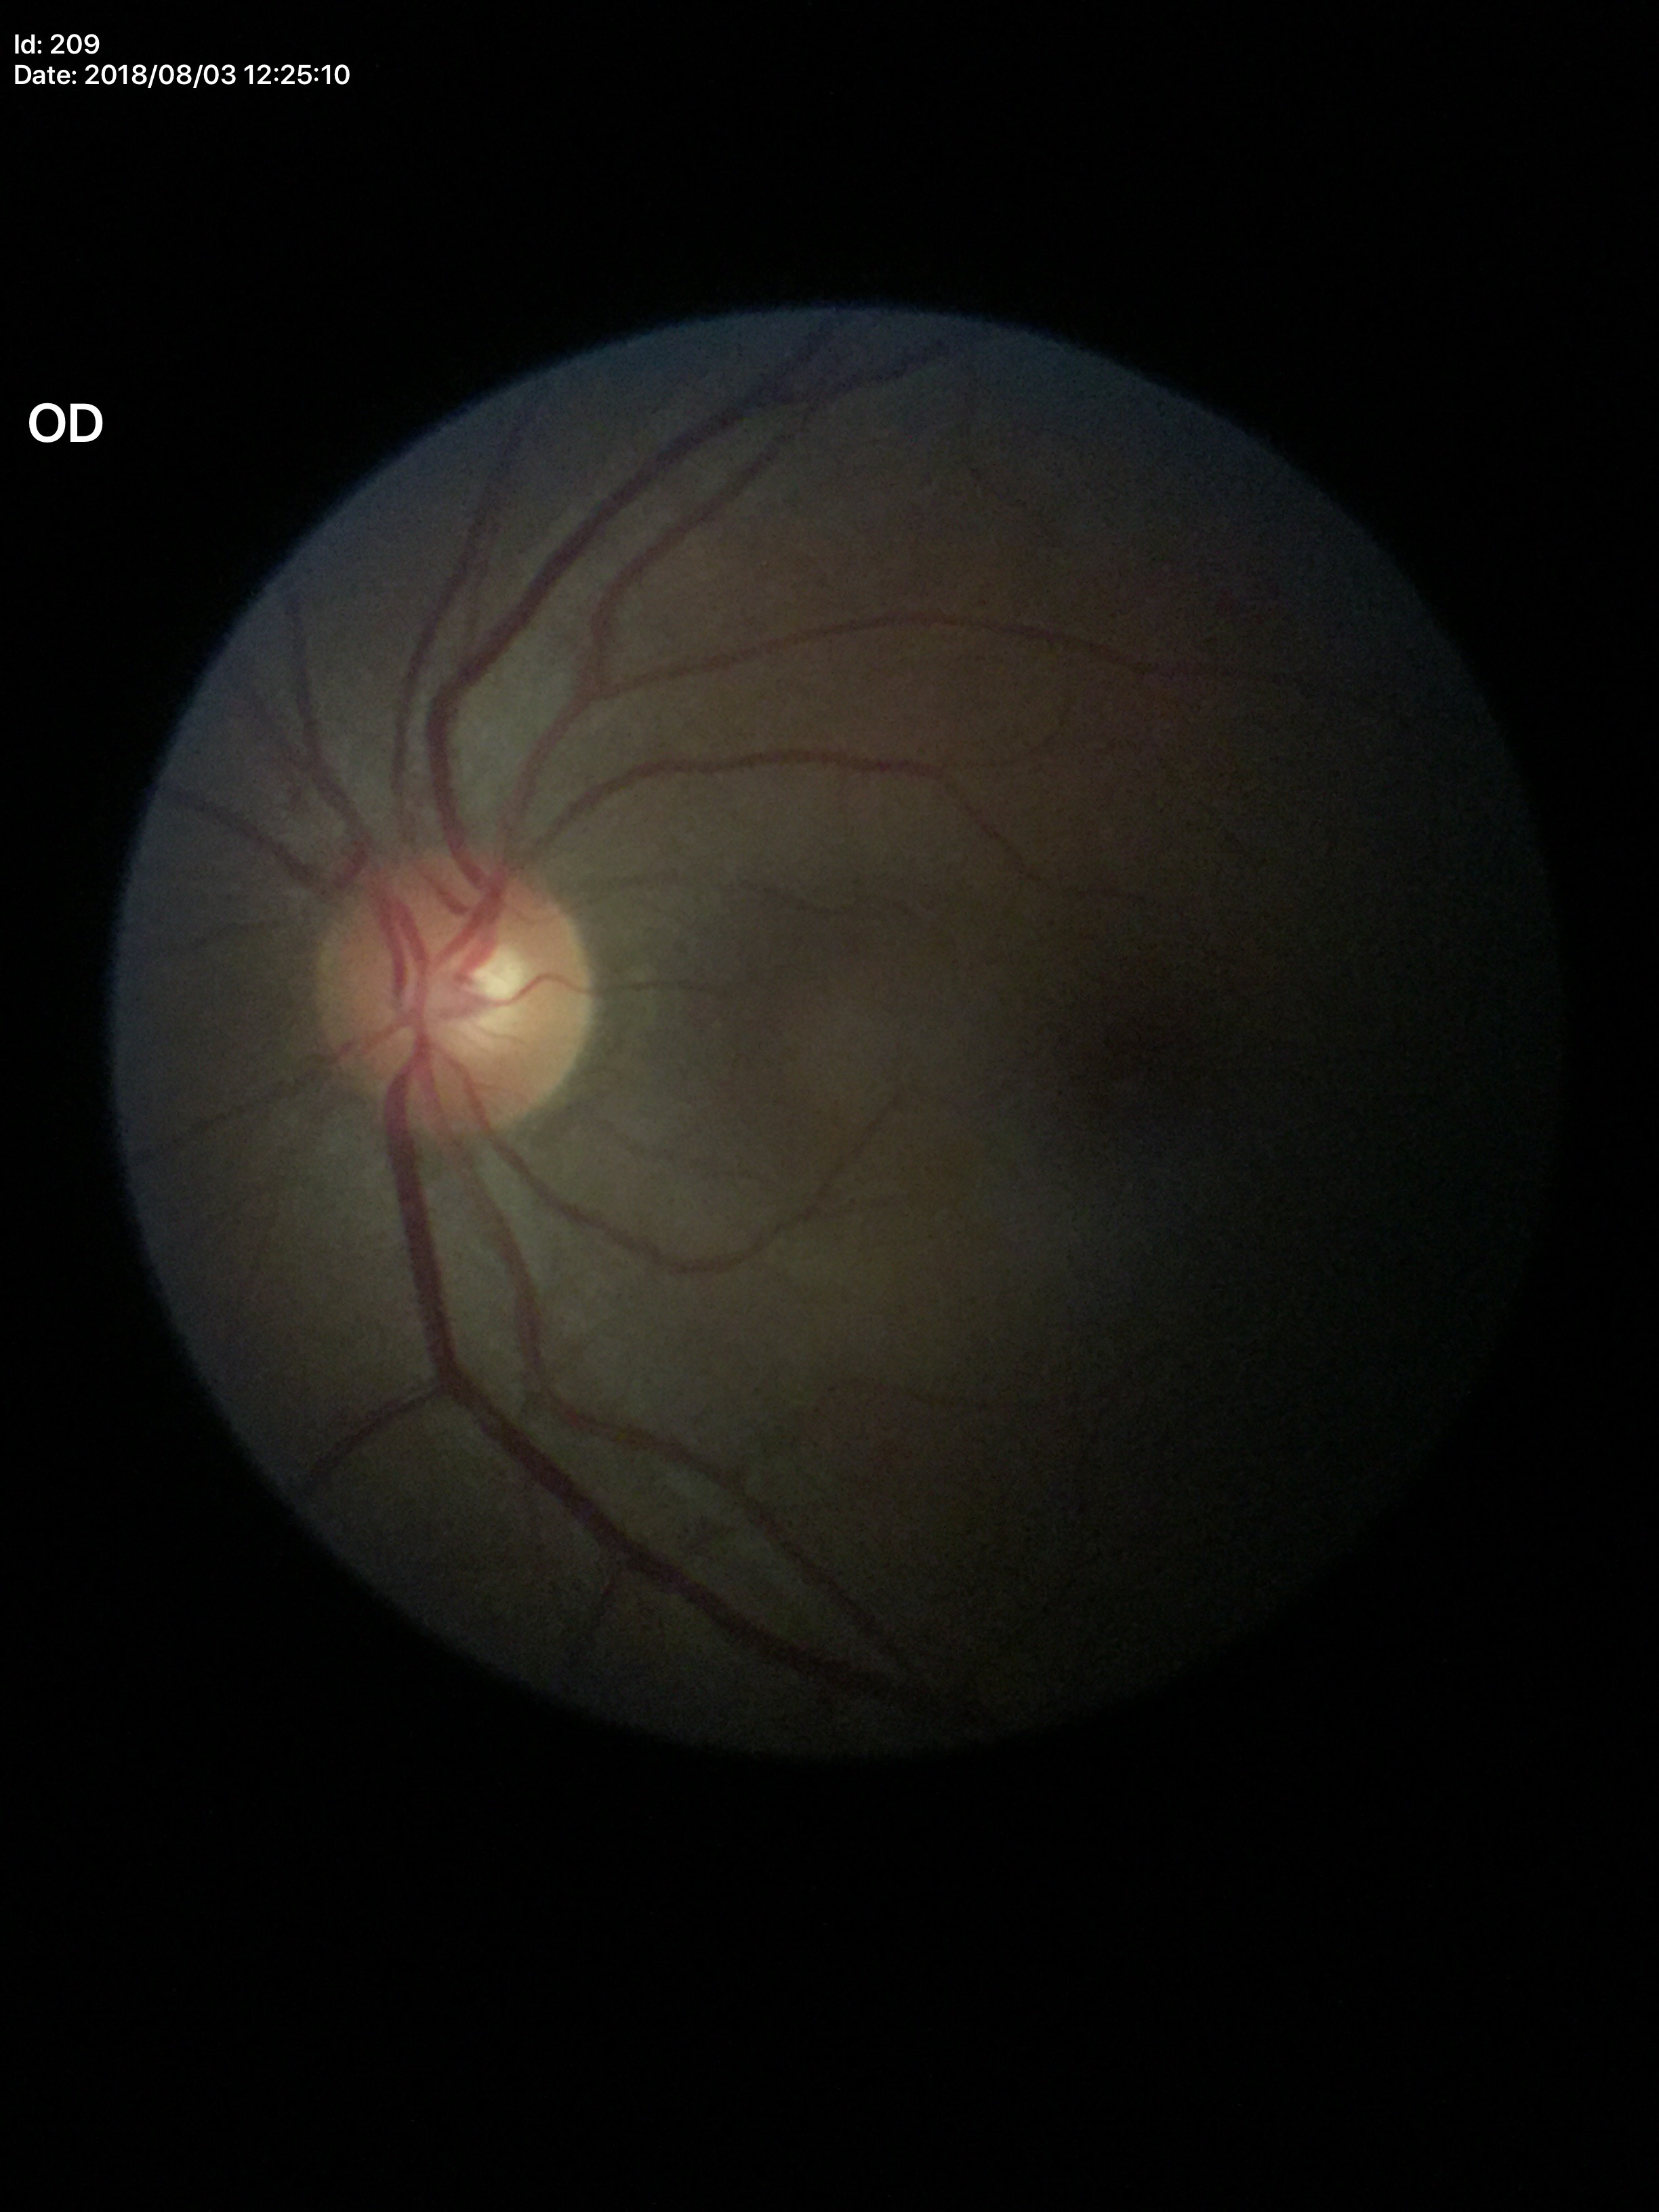
Glaucoma decision: negative | vertical cup-to-disc ratio (VCDR): 0.48